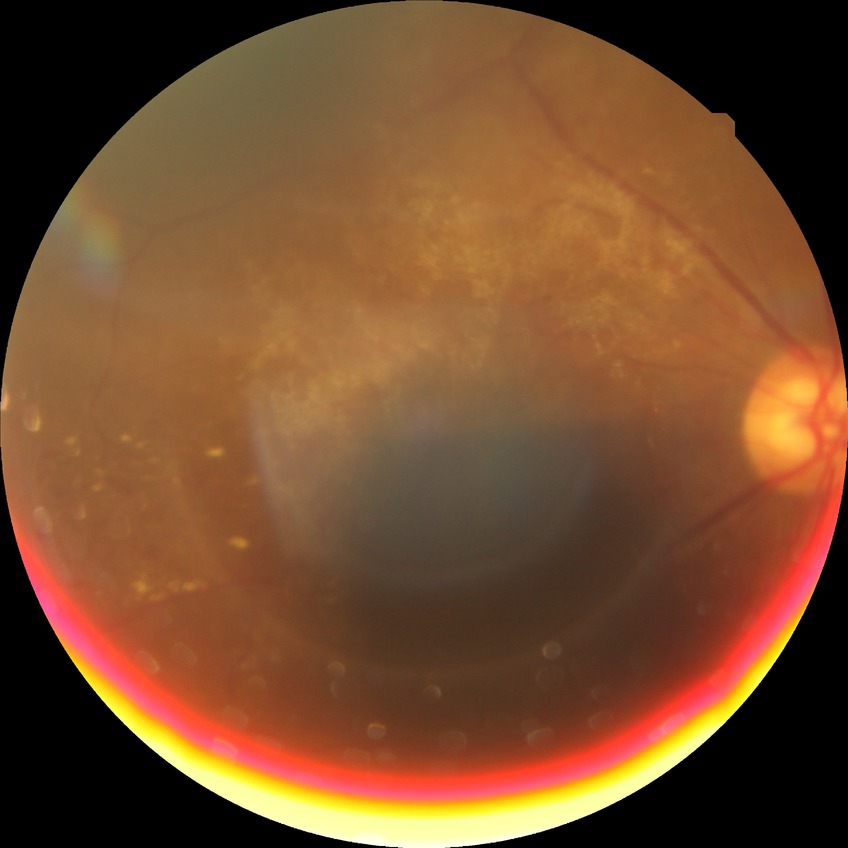 Davis DR grade is PDR.